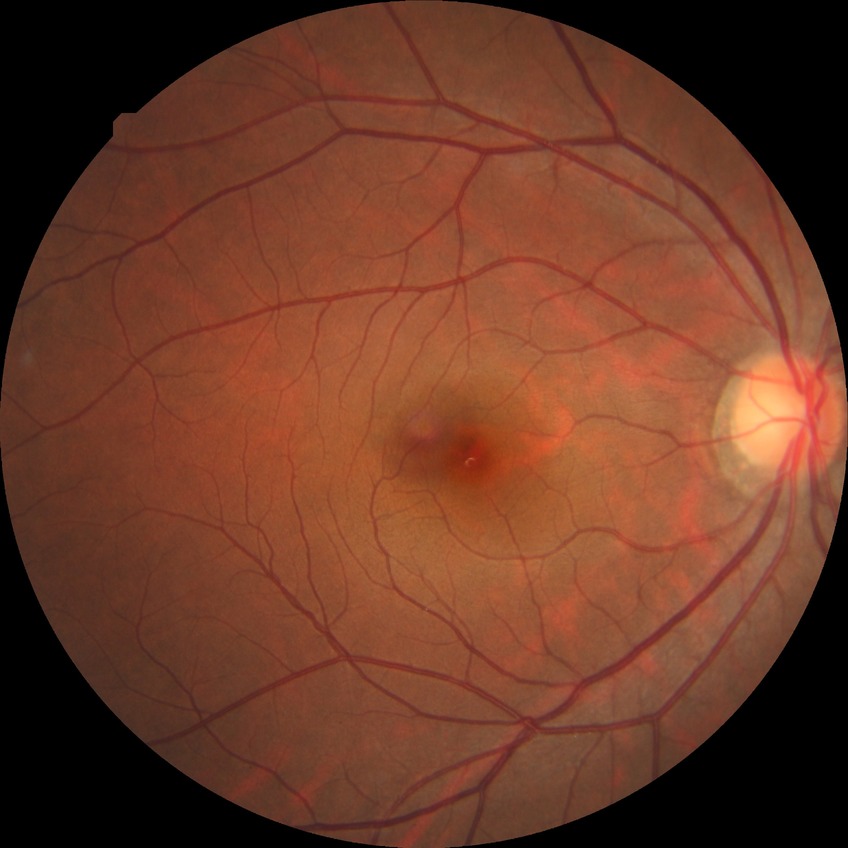
  davis_grade: NDR (no diabetic retinopathy)